Acquired on the Phoenix ICON · infant wide-field retinal image:
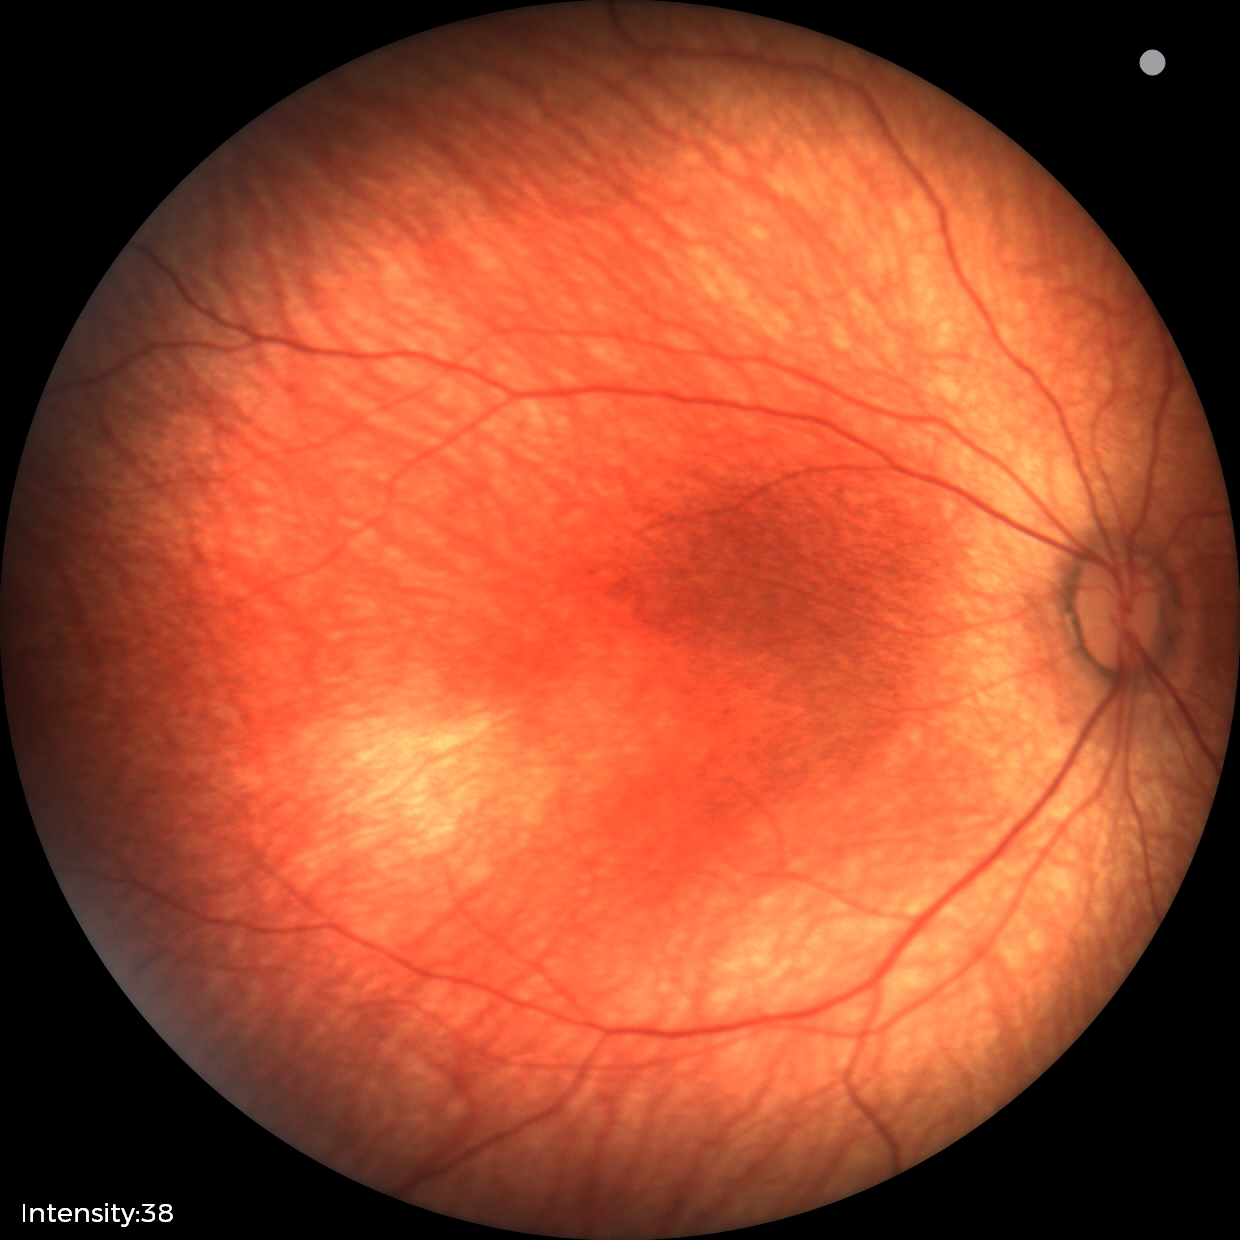
Physiological retinal appearance for postconceptual age.